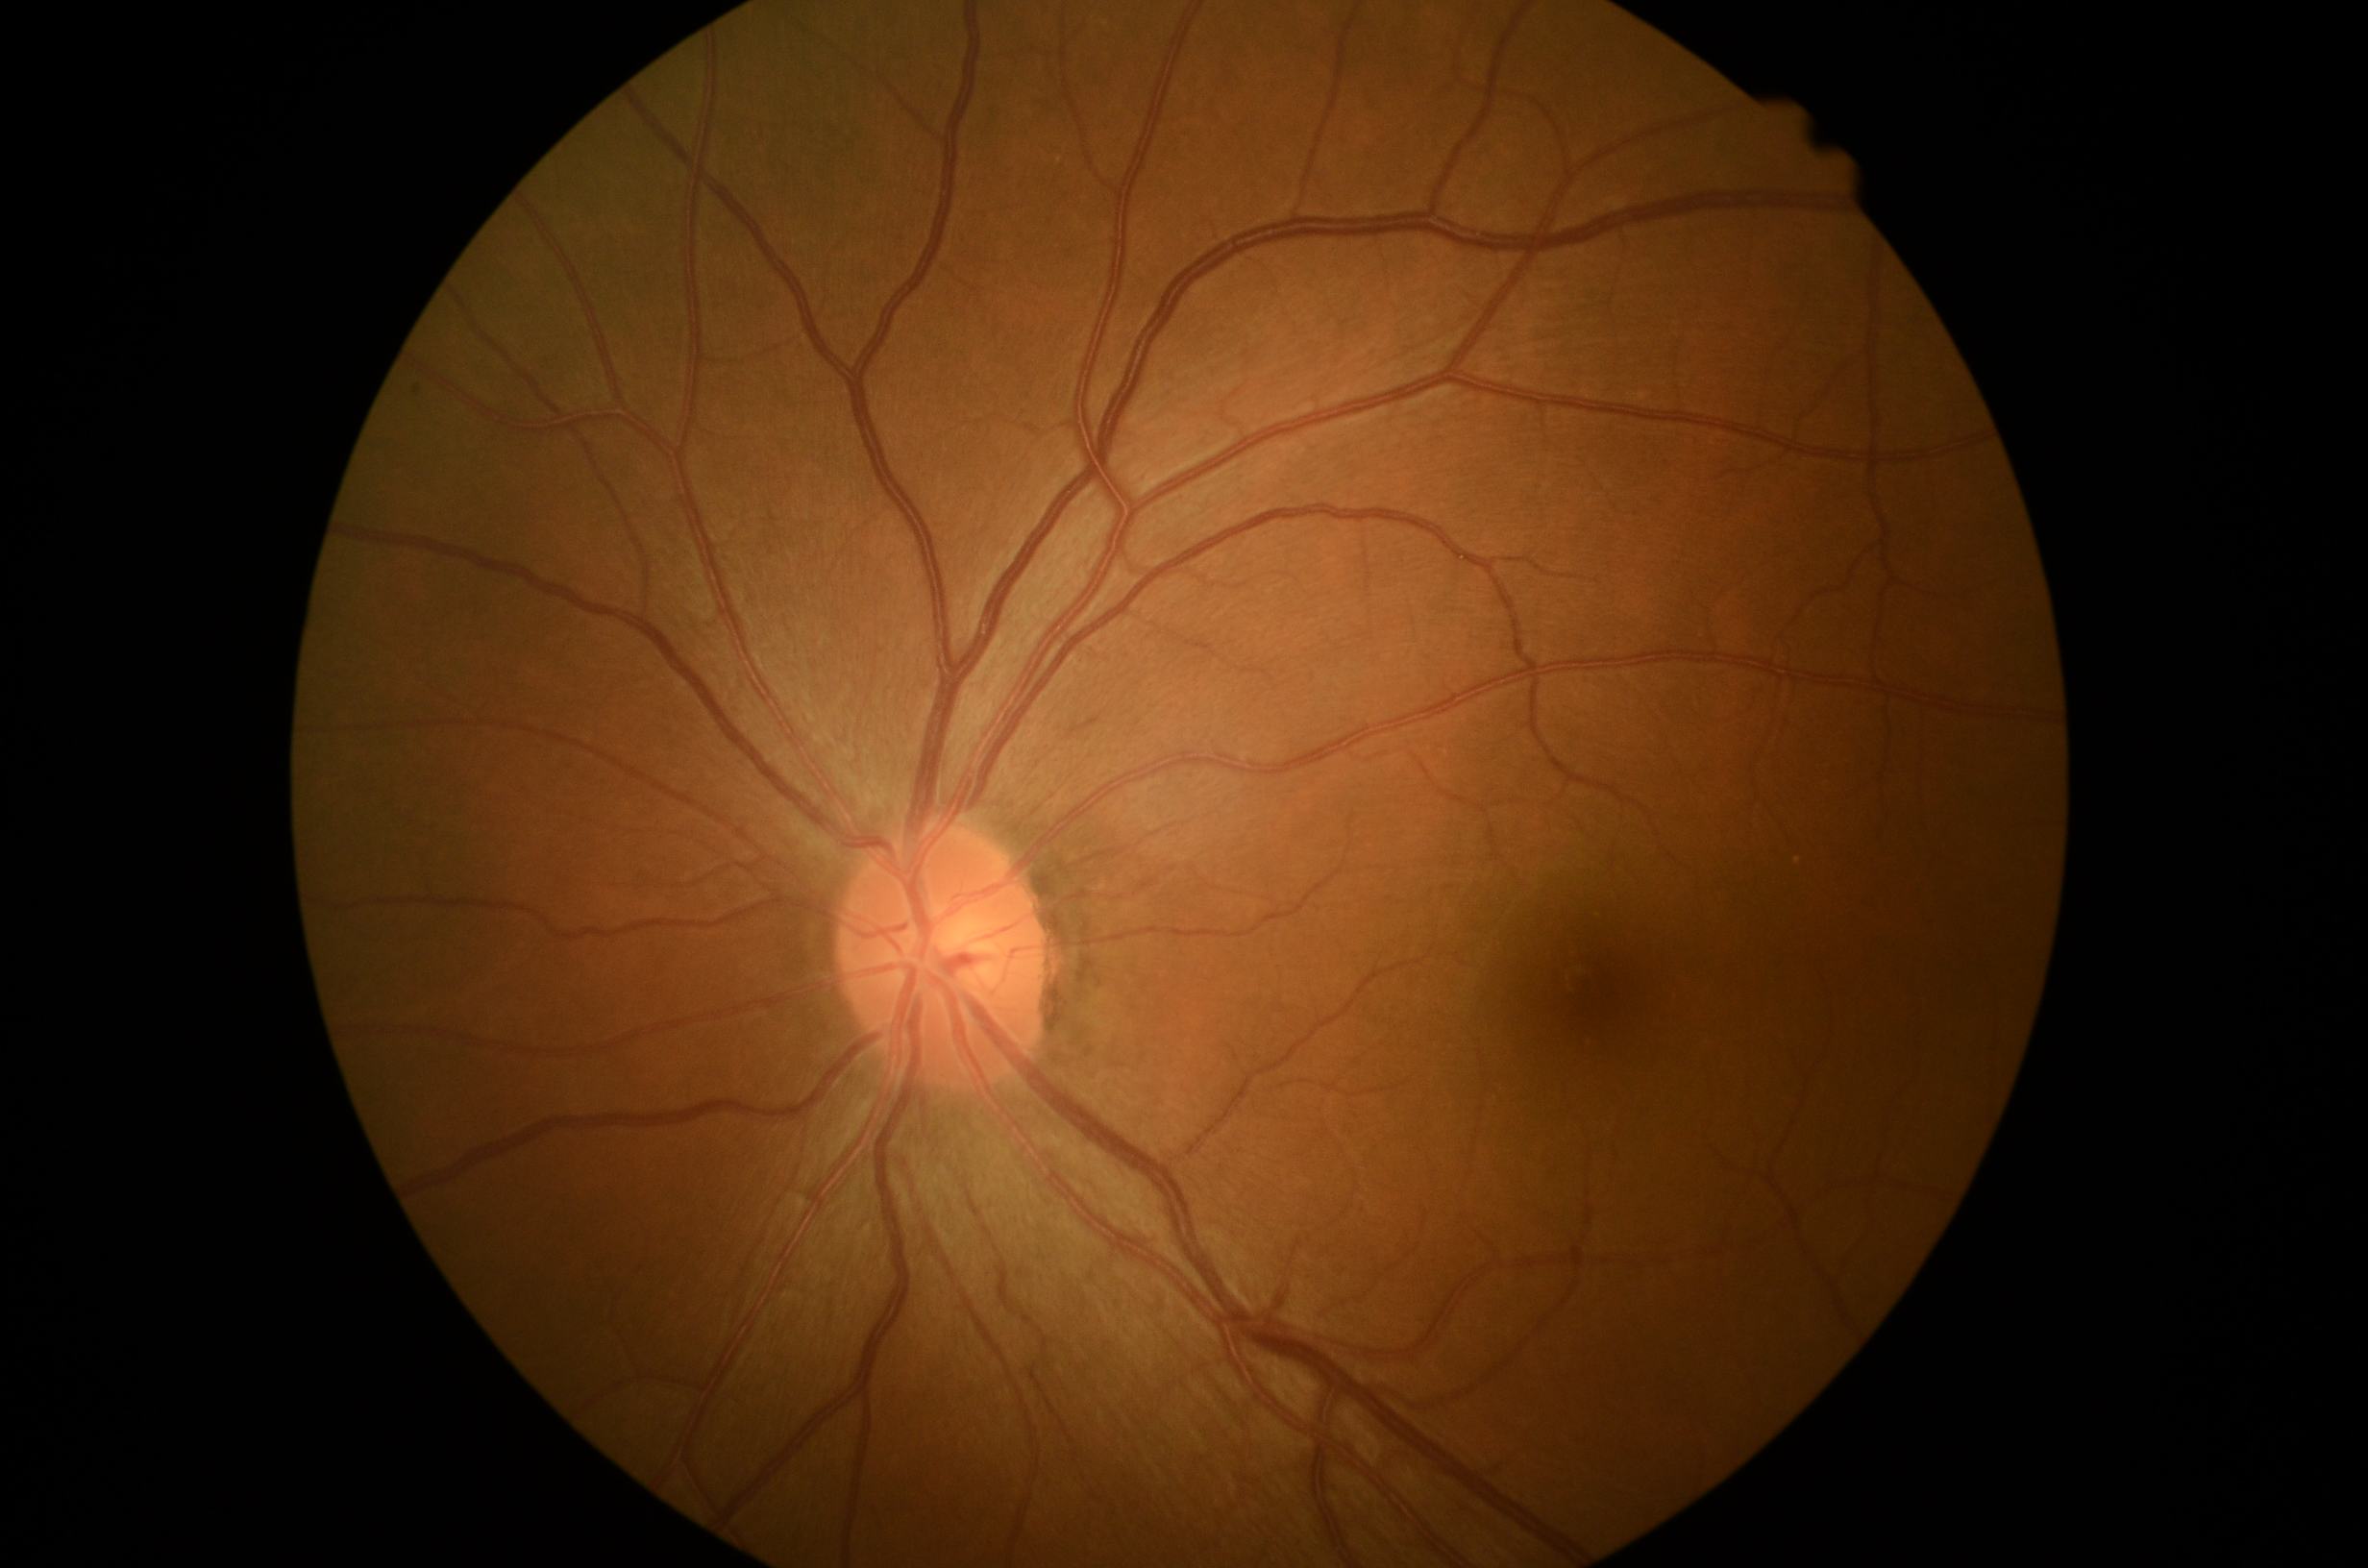

DR severity: no apparent diabetic retinopathy (grade 0).